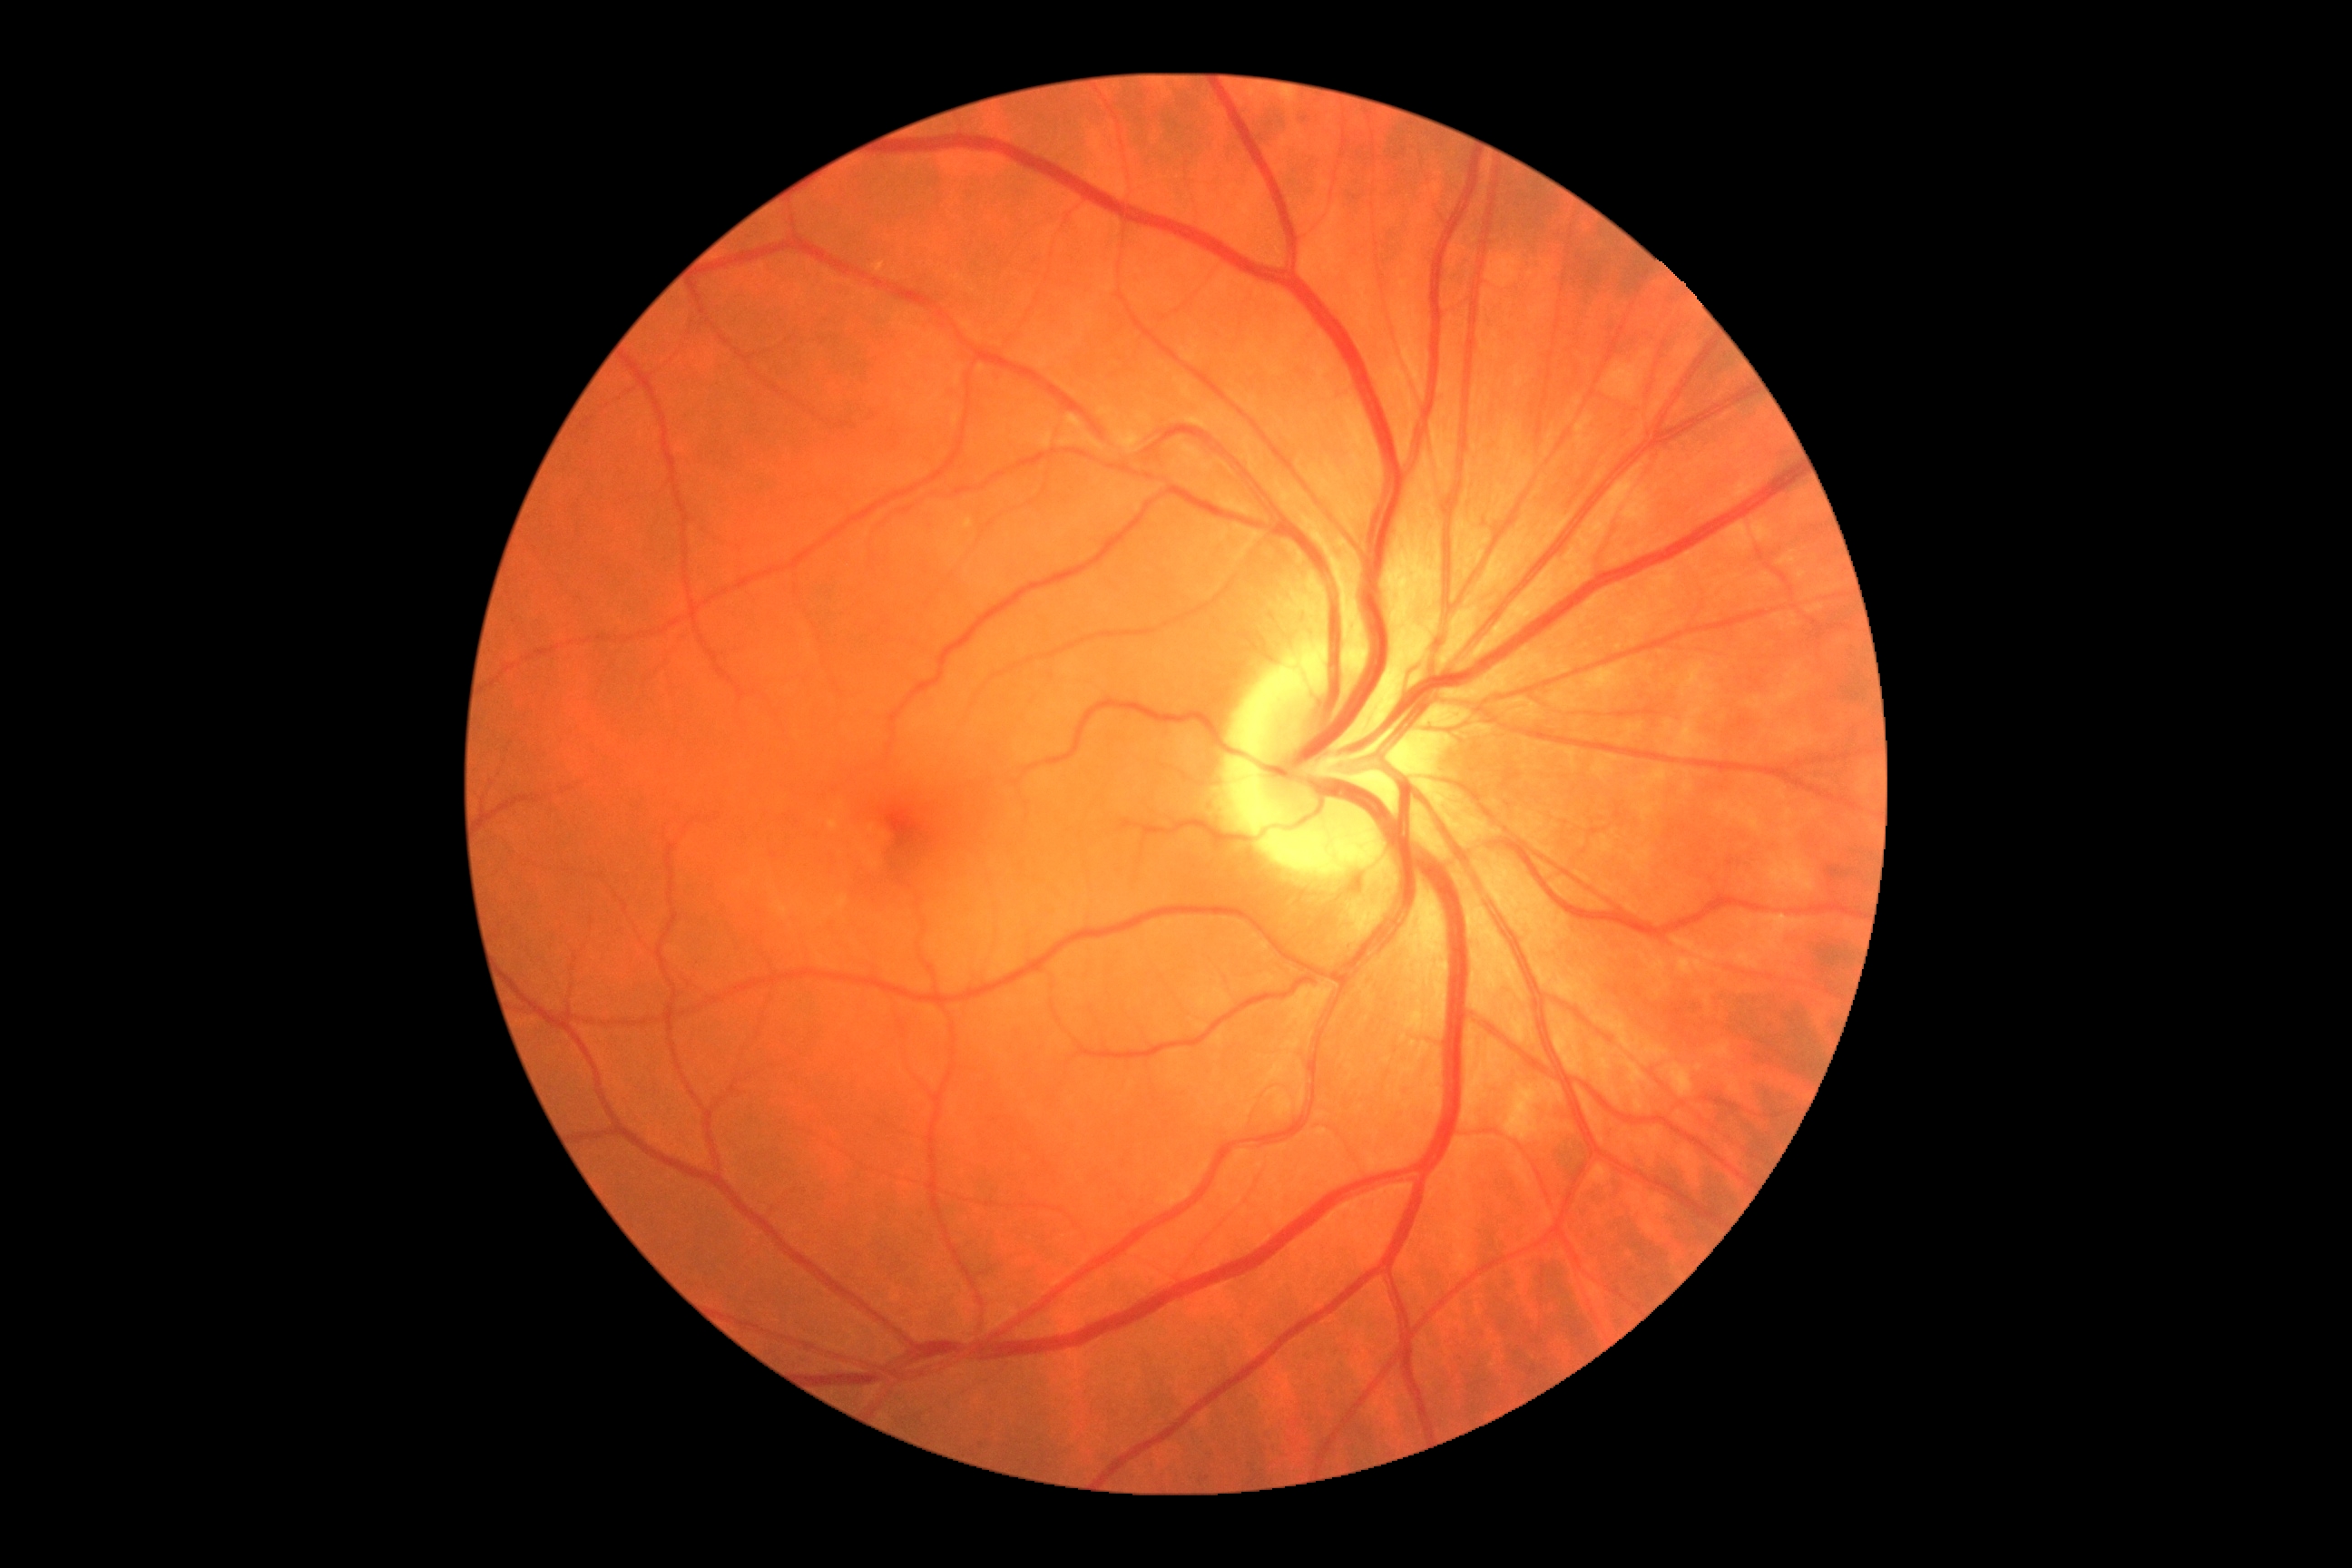 Findings:
• DR impression — no signs of DR
• diabetic retinopathy (DR) — grade 0 (no apparent retinopathy)